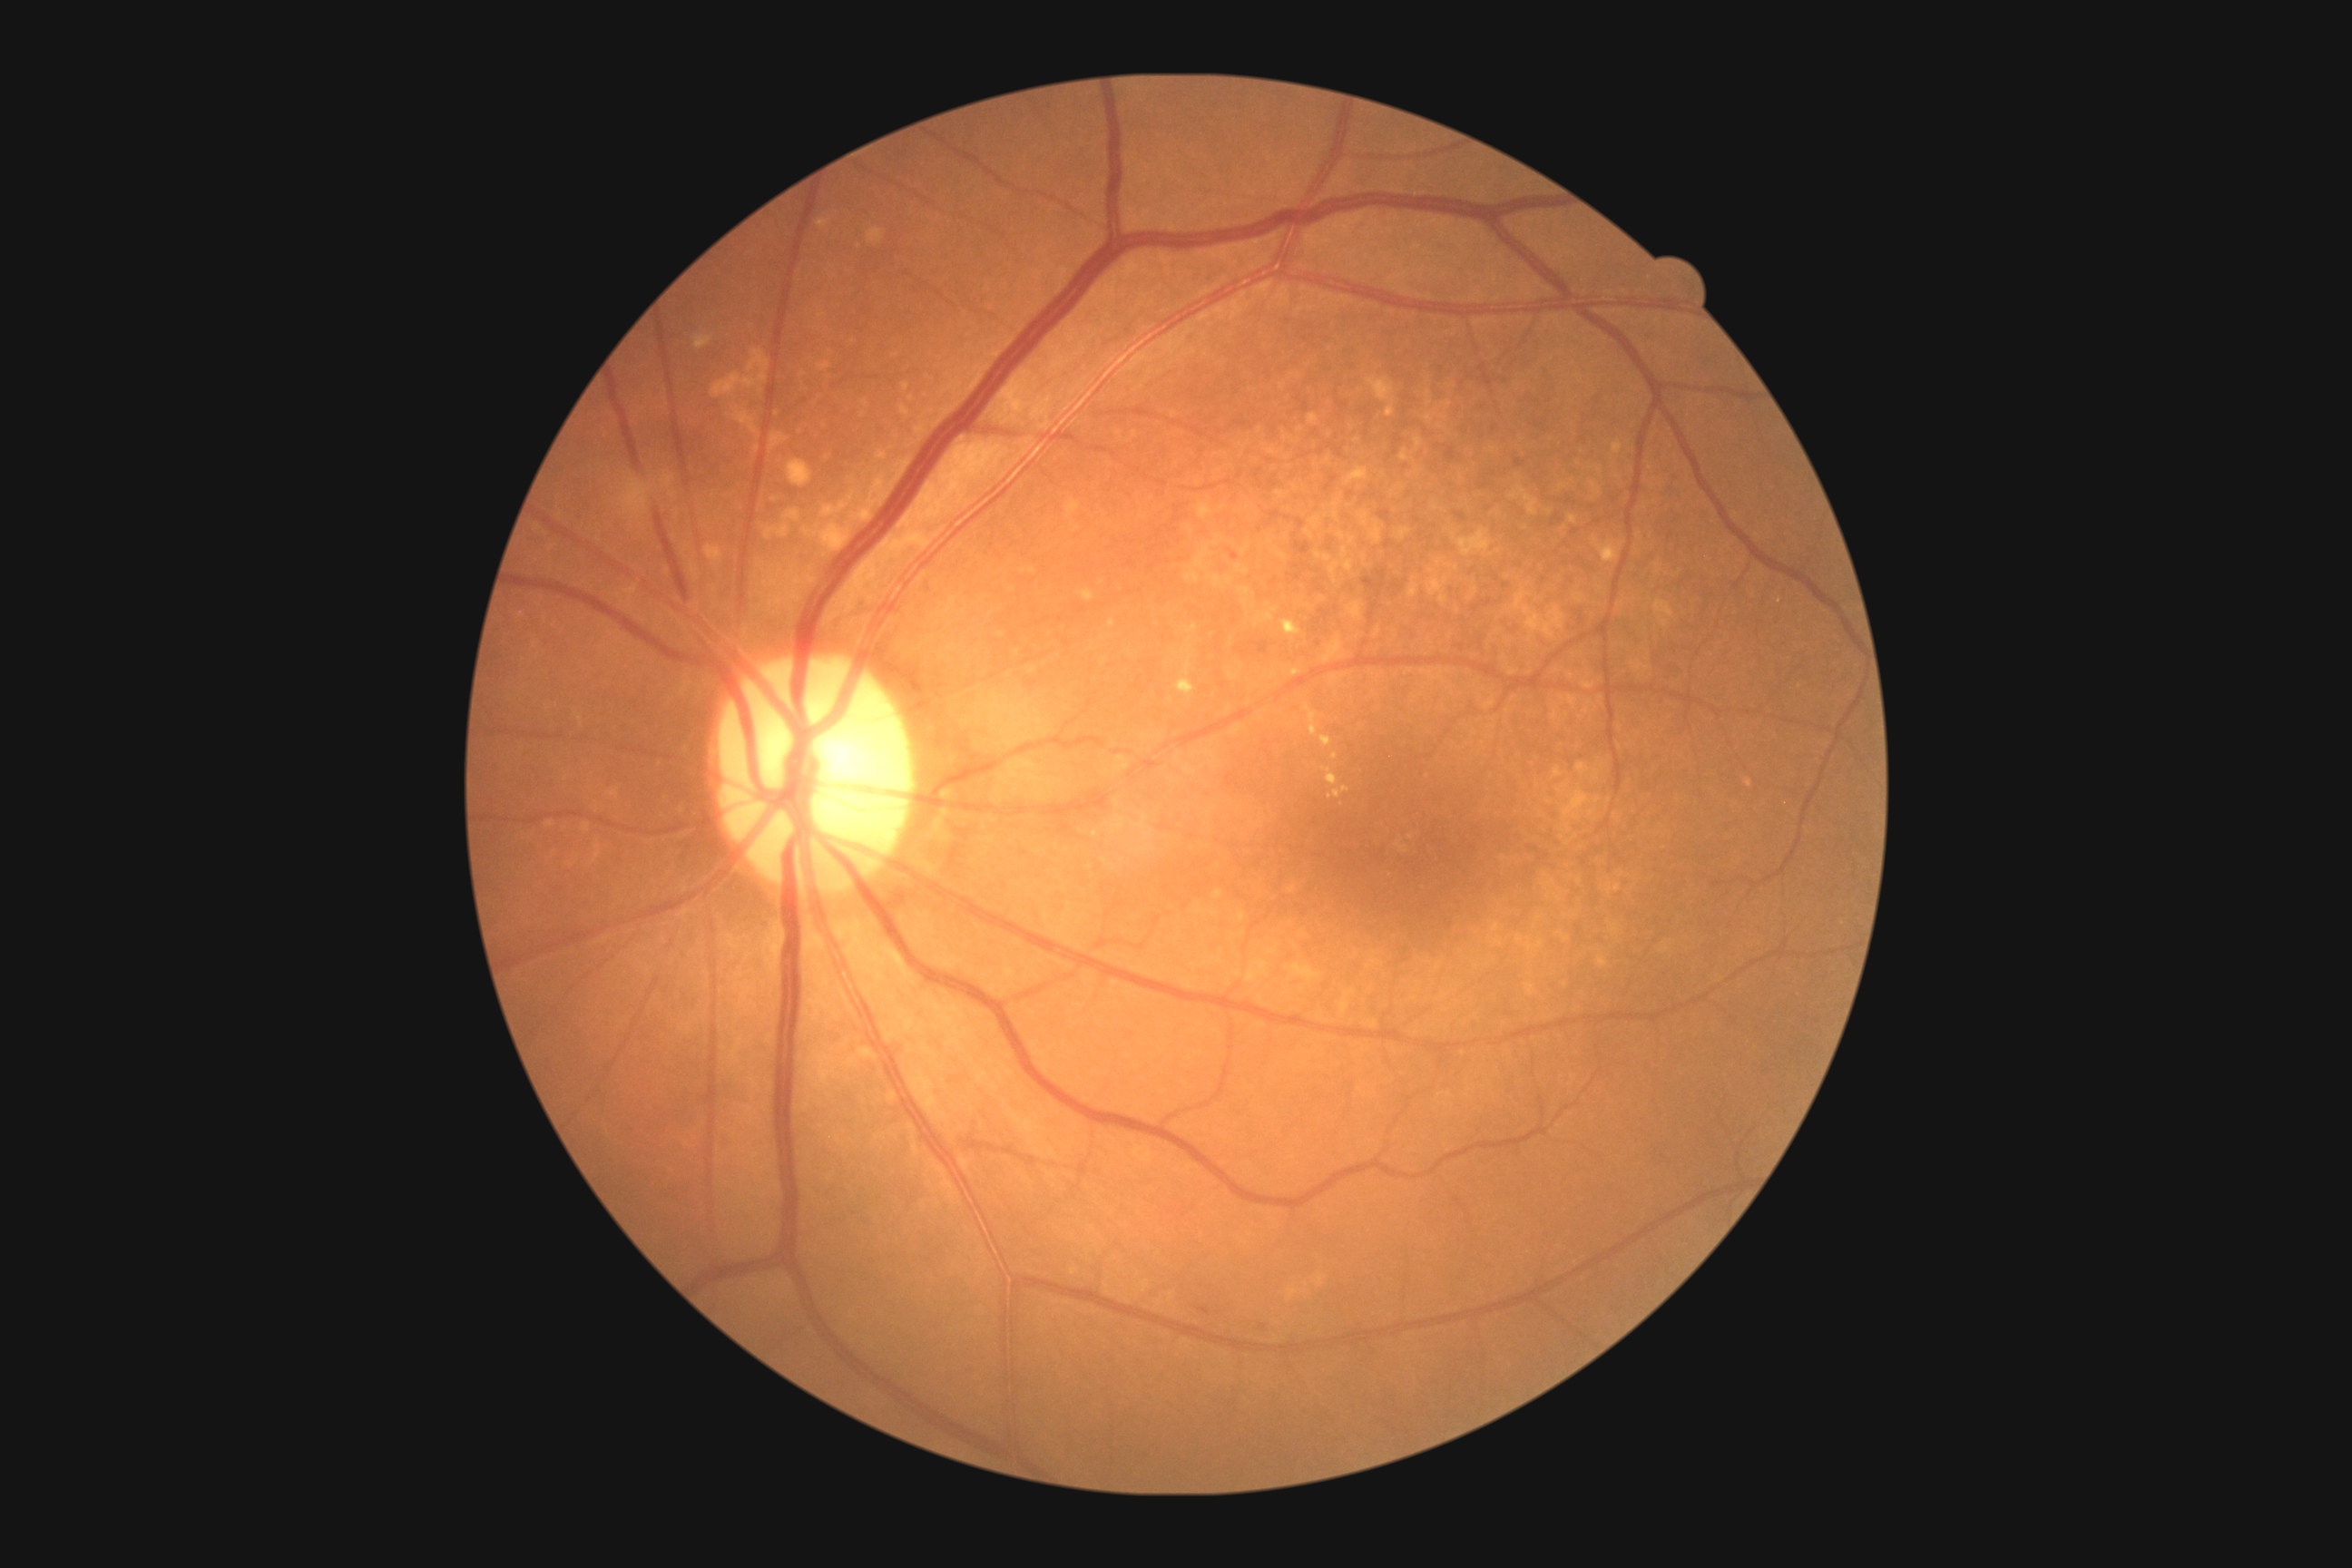 diabetic retinopathy grade: 2.